Captured with the Clarity RetCam 3 (130° field of view). Infant wide-field retinal image: 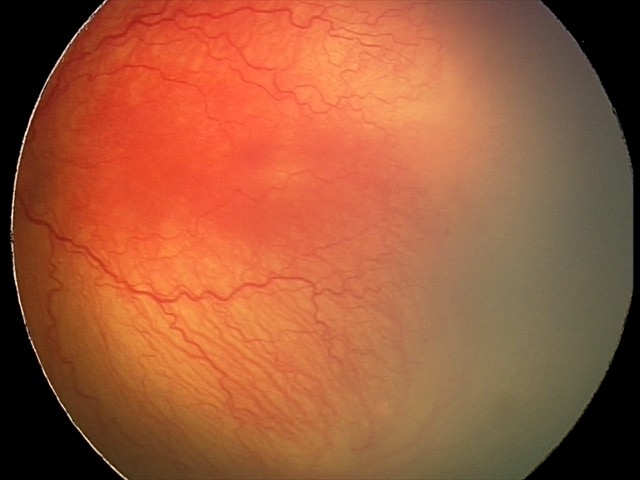

Screening: aggressive retinopathy of prematurity (A-ROP); plus disease.